512 by 512 pixels.
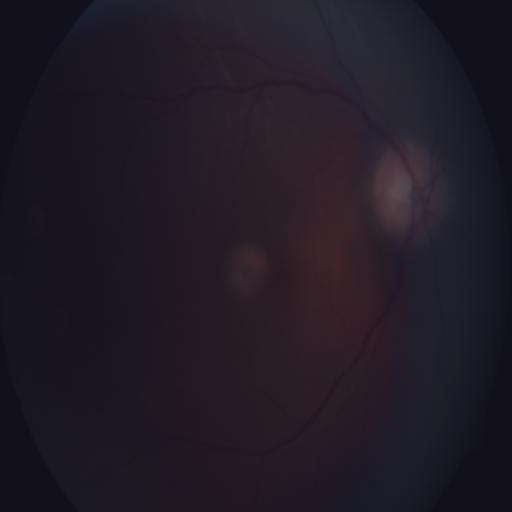
Impression: normal fundus.